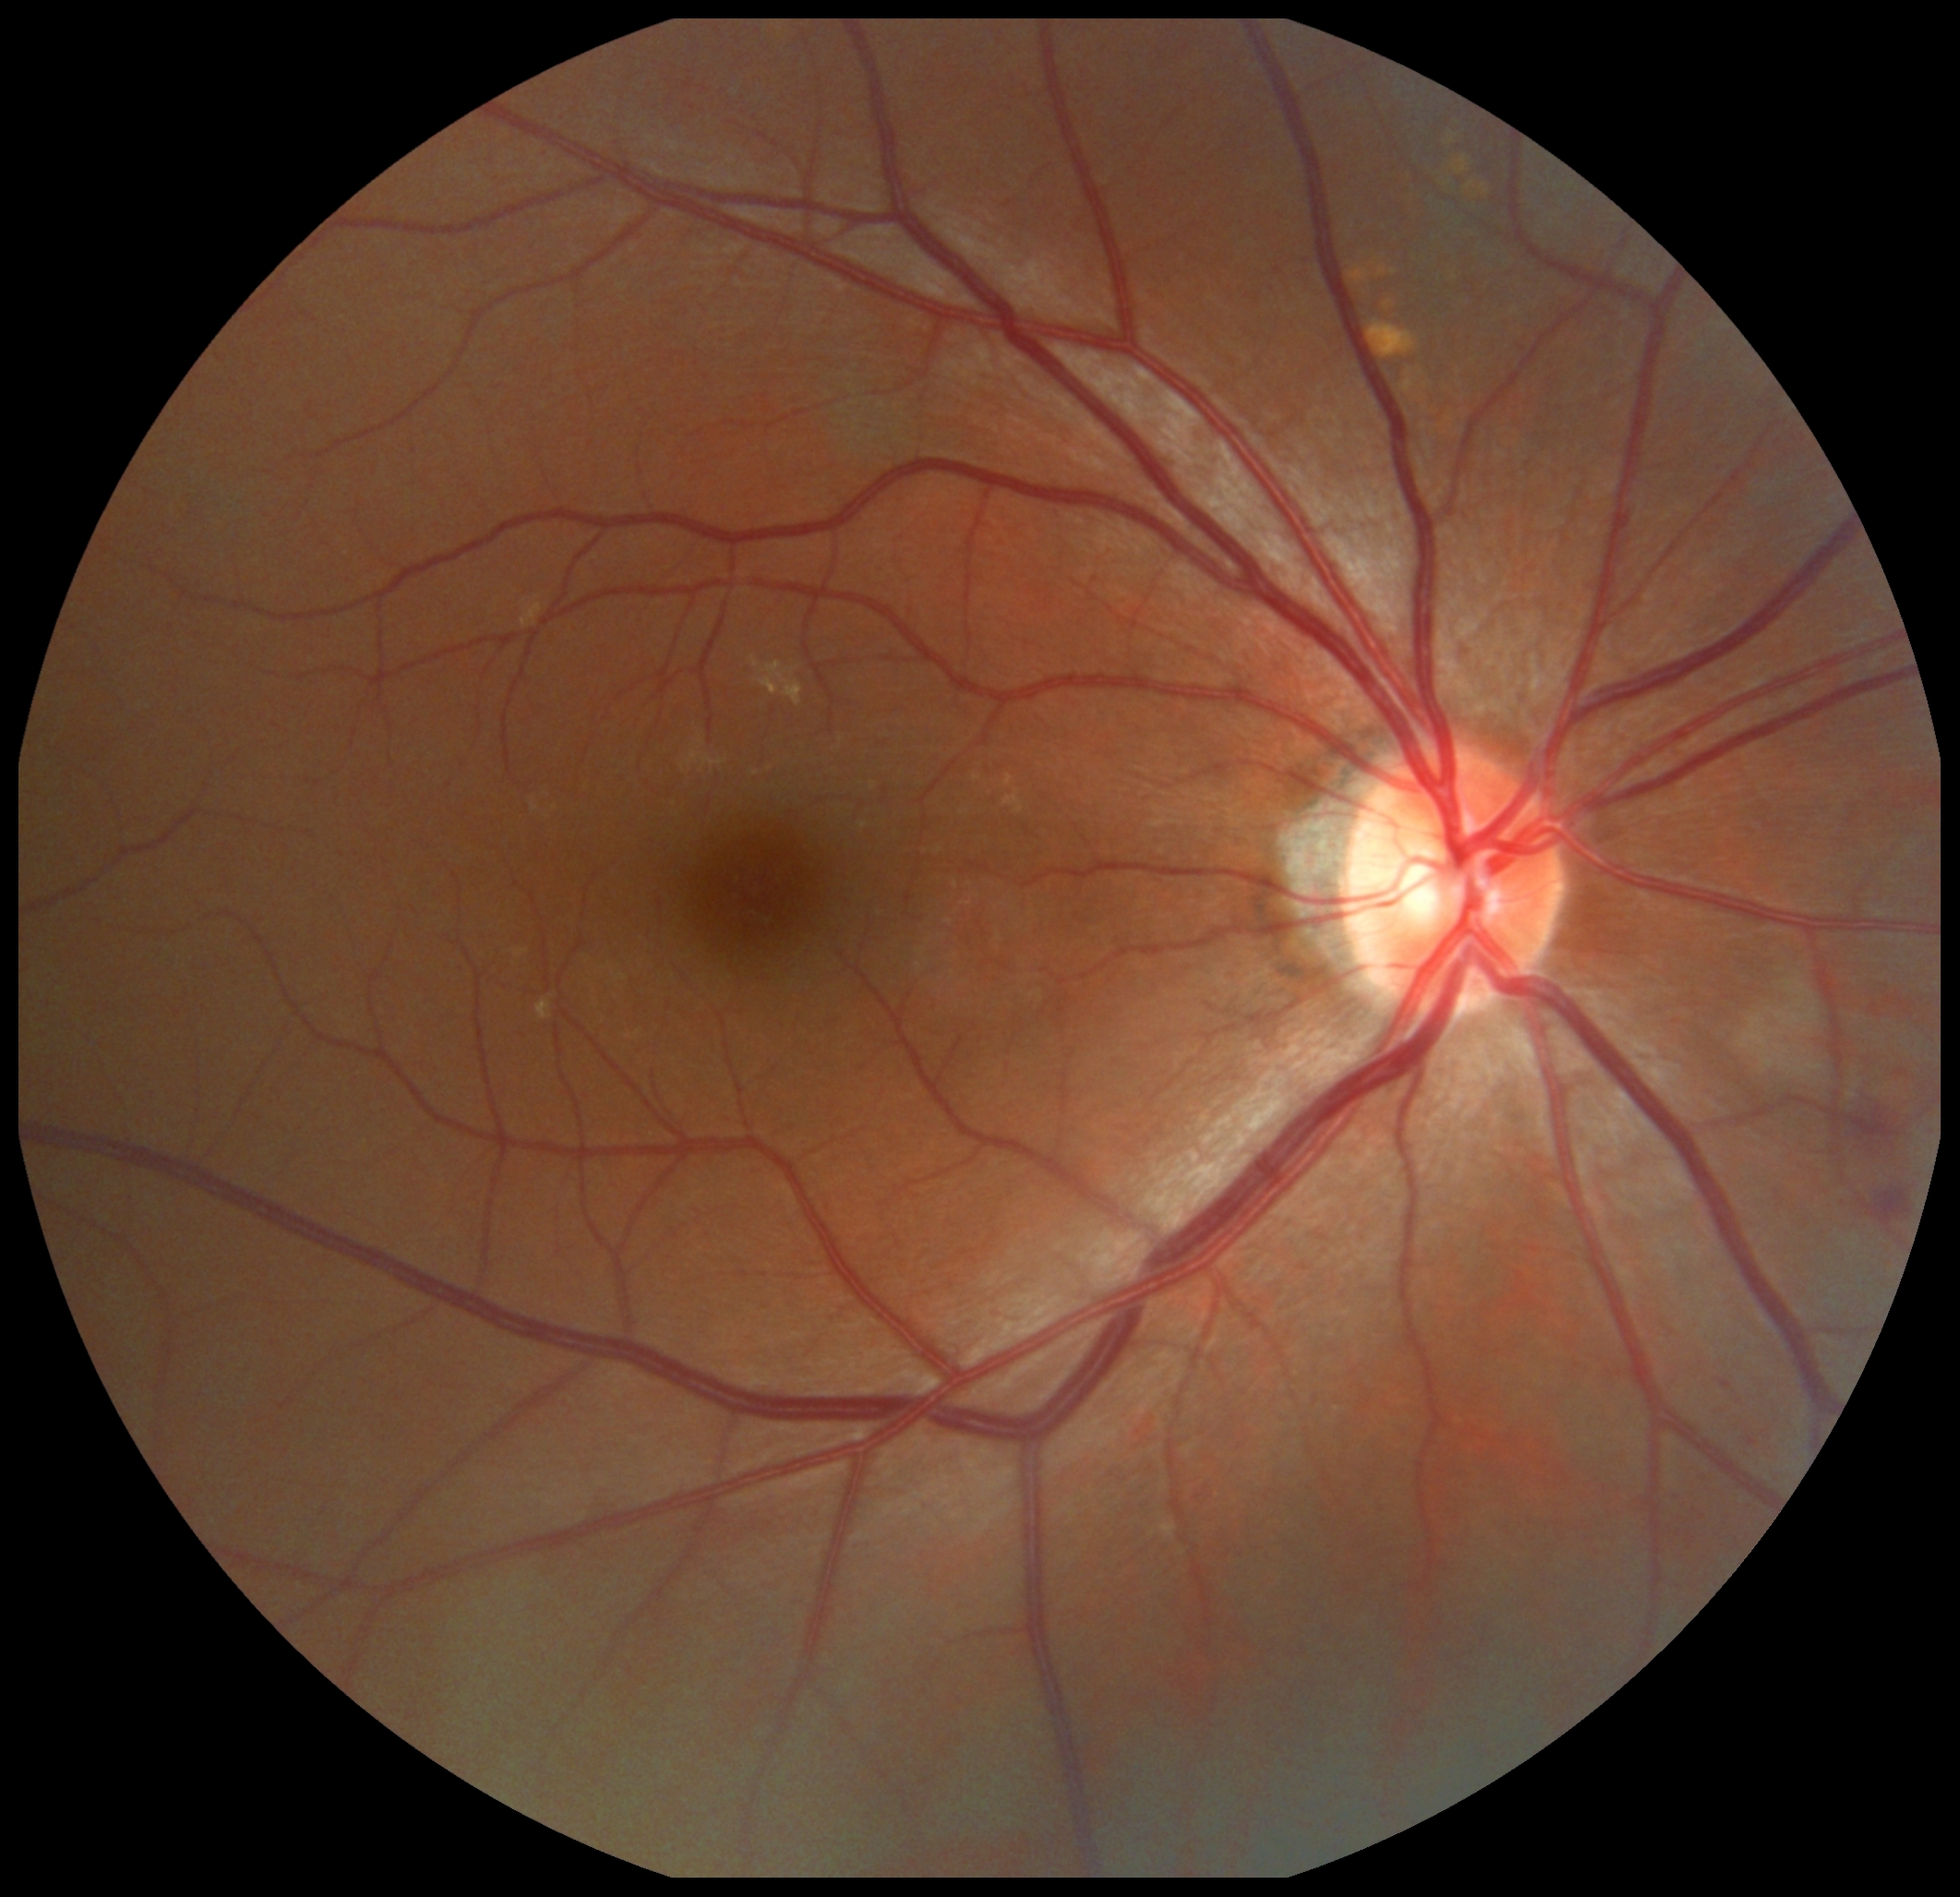 Diabetic retinopathy: grade 2. The retinopathy is classified as non-proliferative diabetic retinopathy.